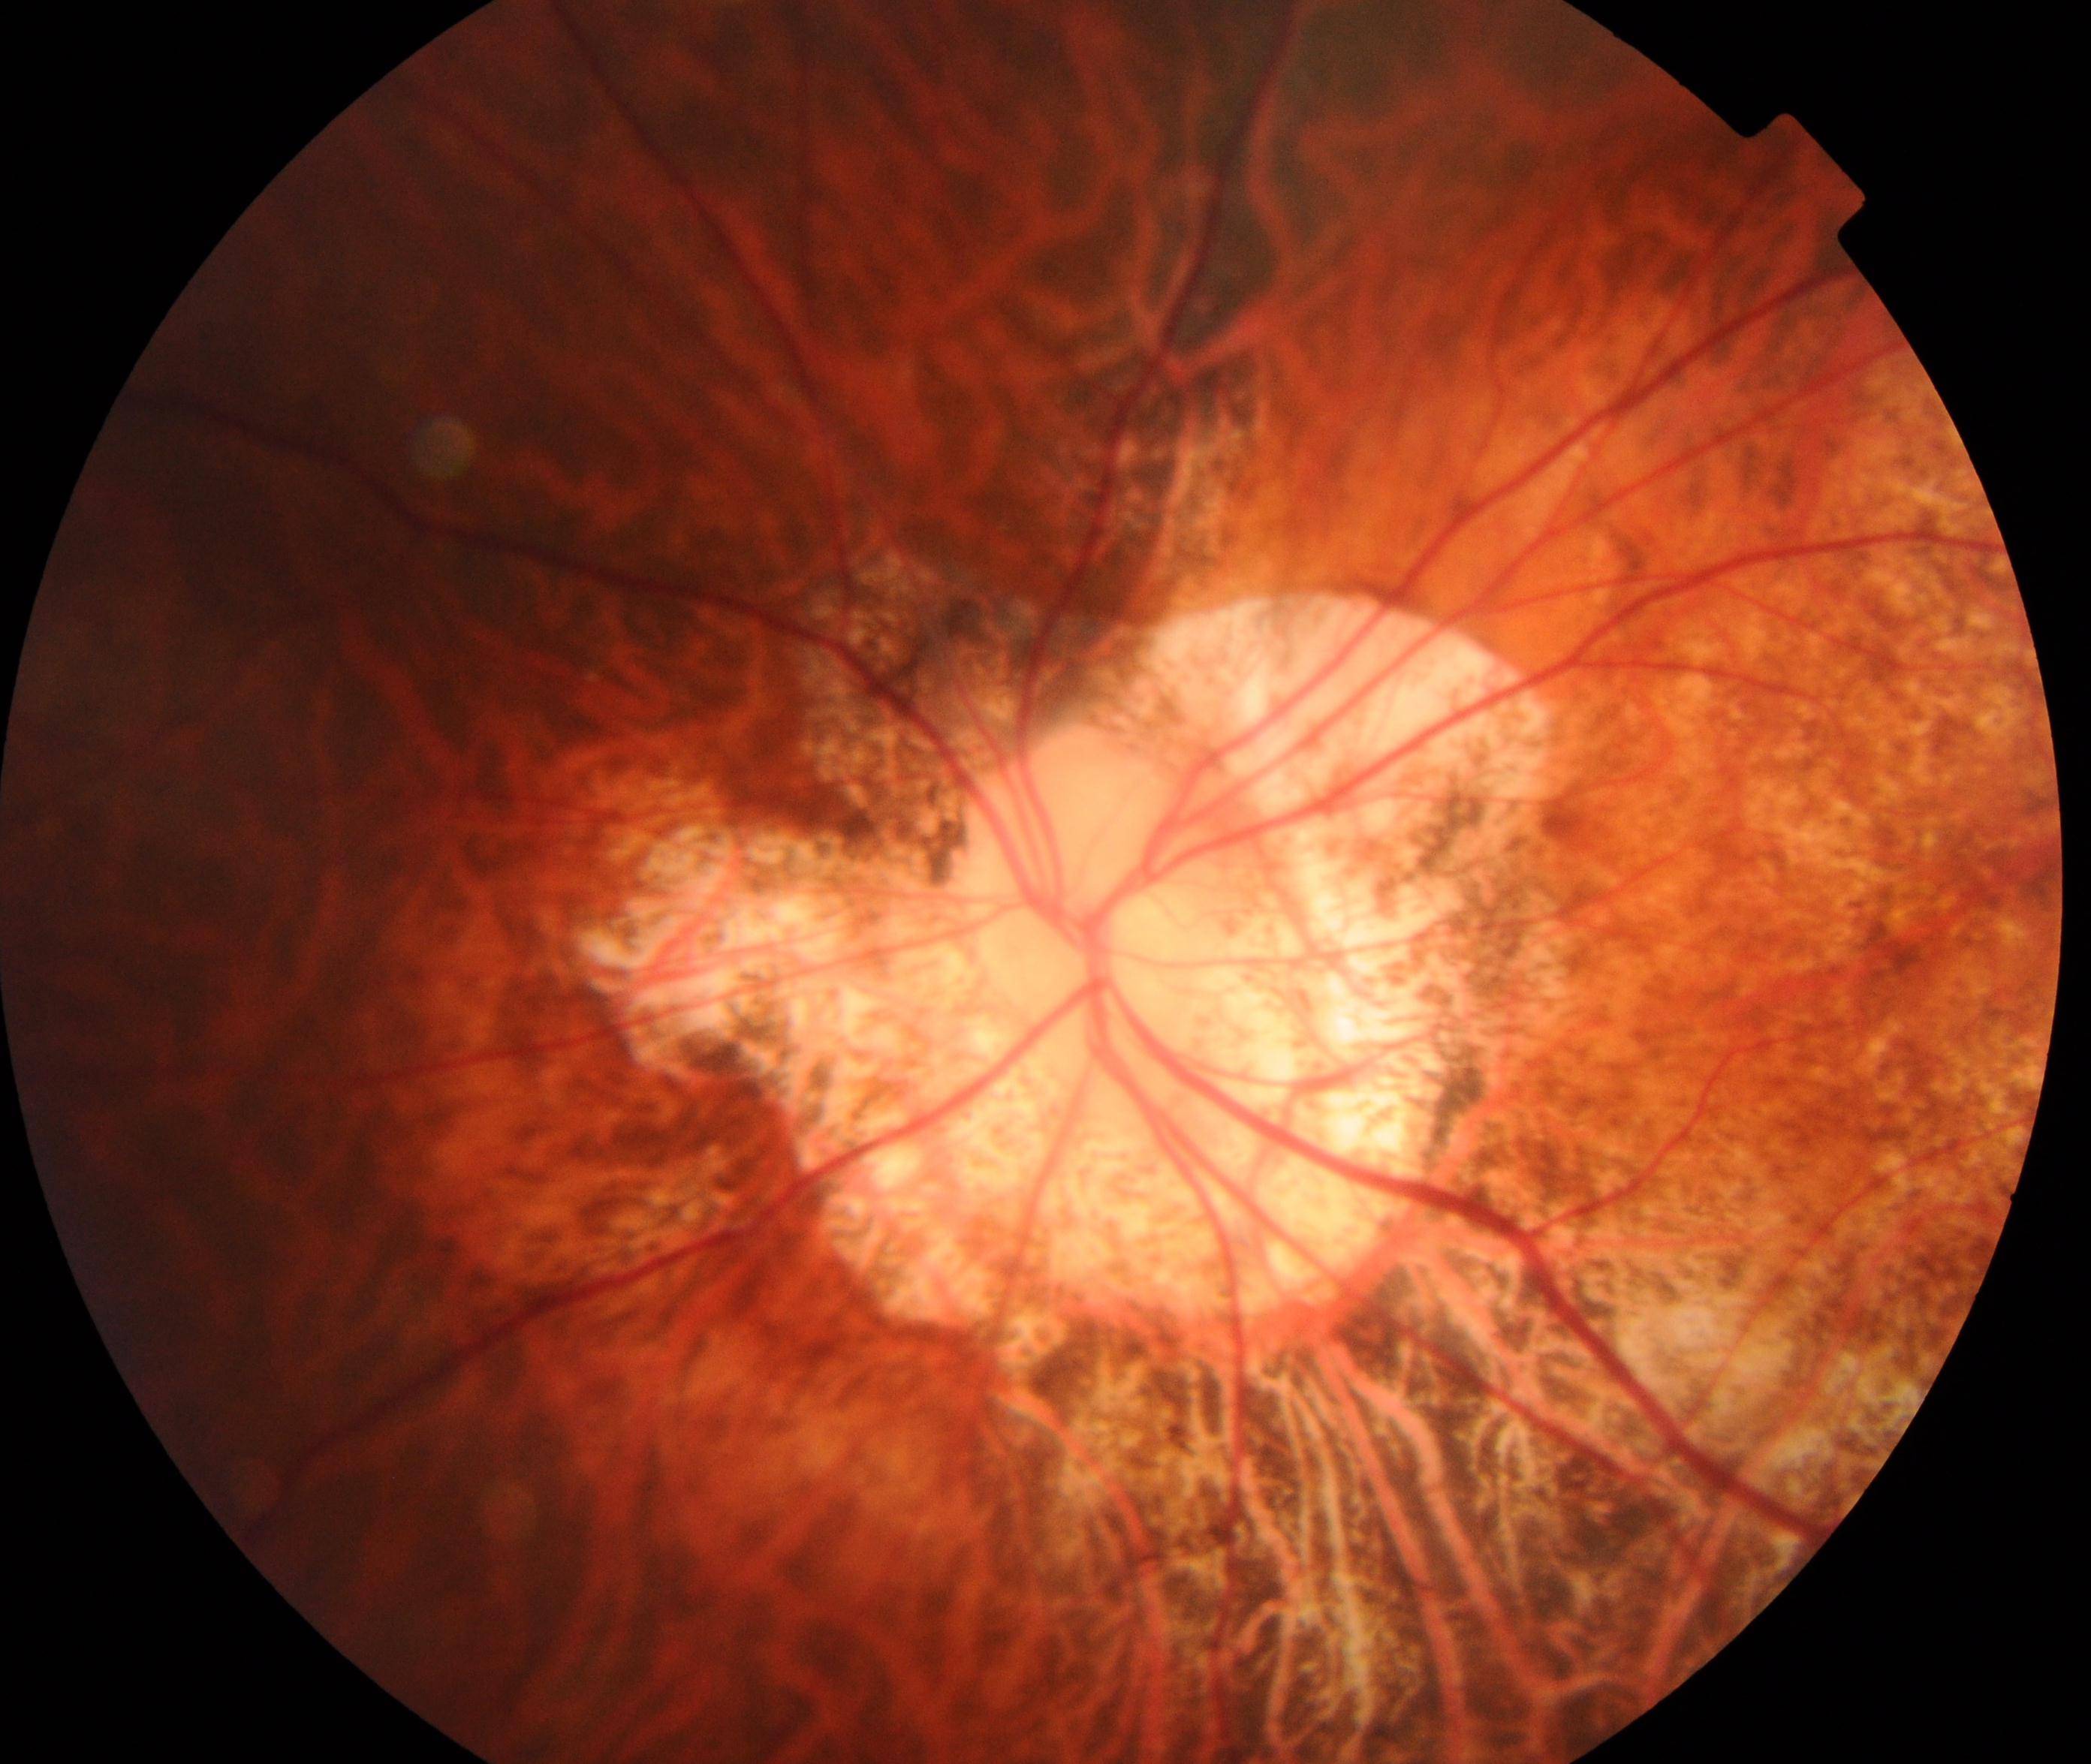

Classification: pathological myopia.